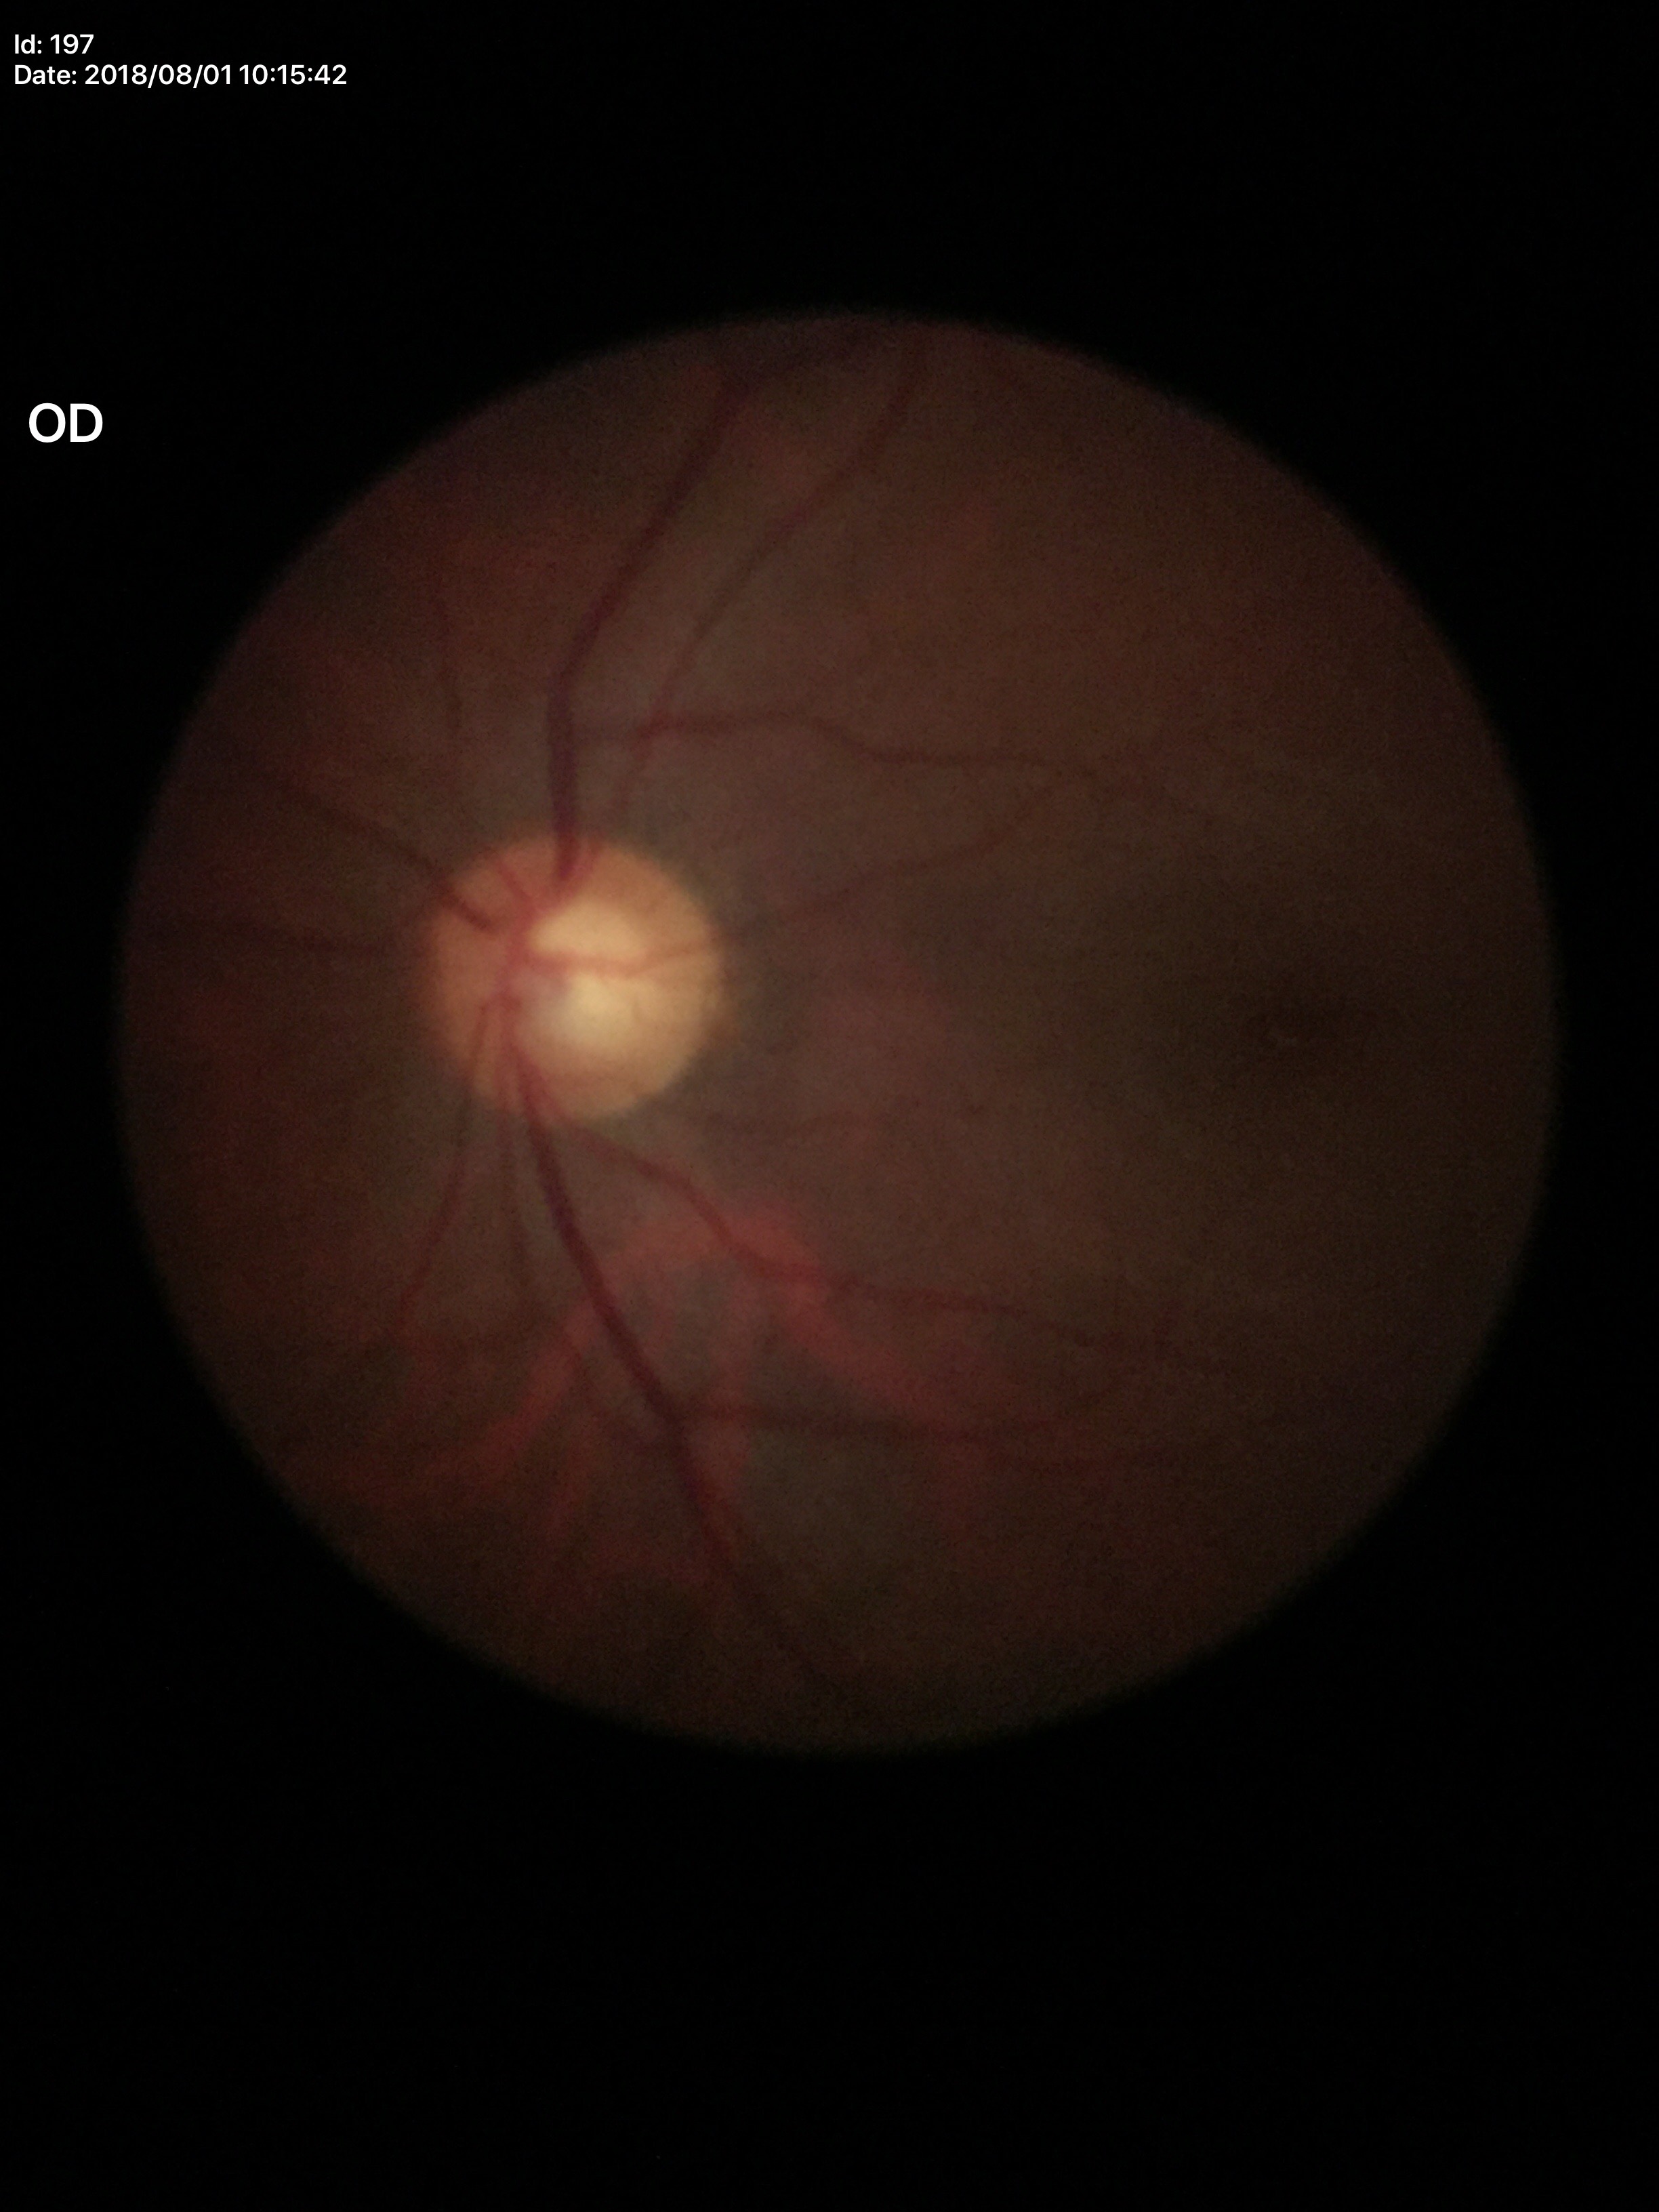

• Glaucoma impression · suspicious findings
• vertical cup-disc ratio (VCDR) · 0.60
• horizontal cup-to-disc ratio (HCDR) · 0.58